45° field of view — 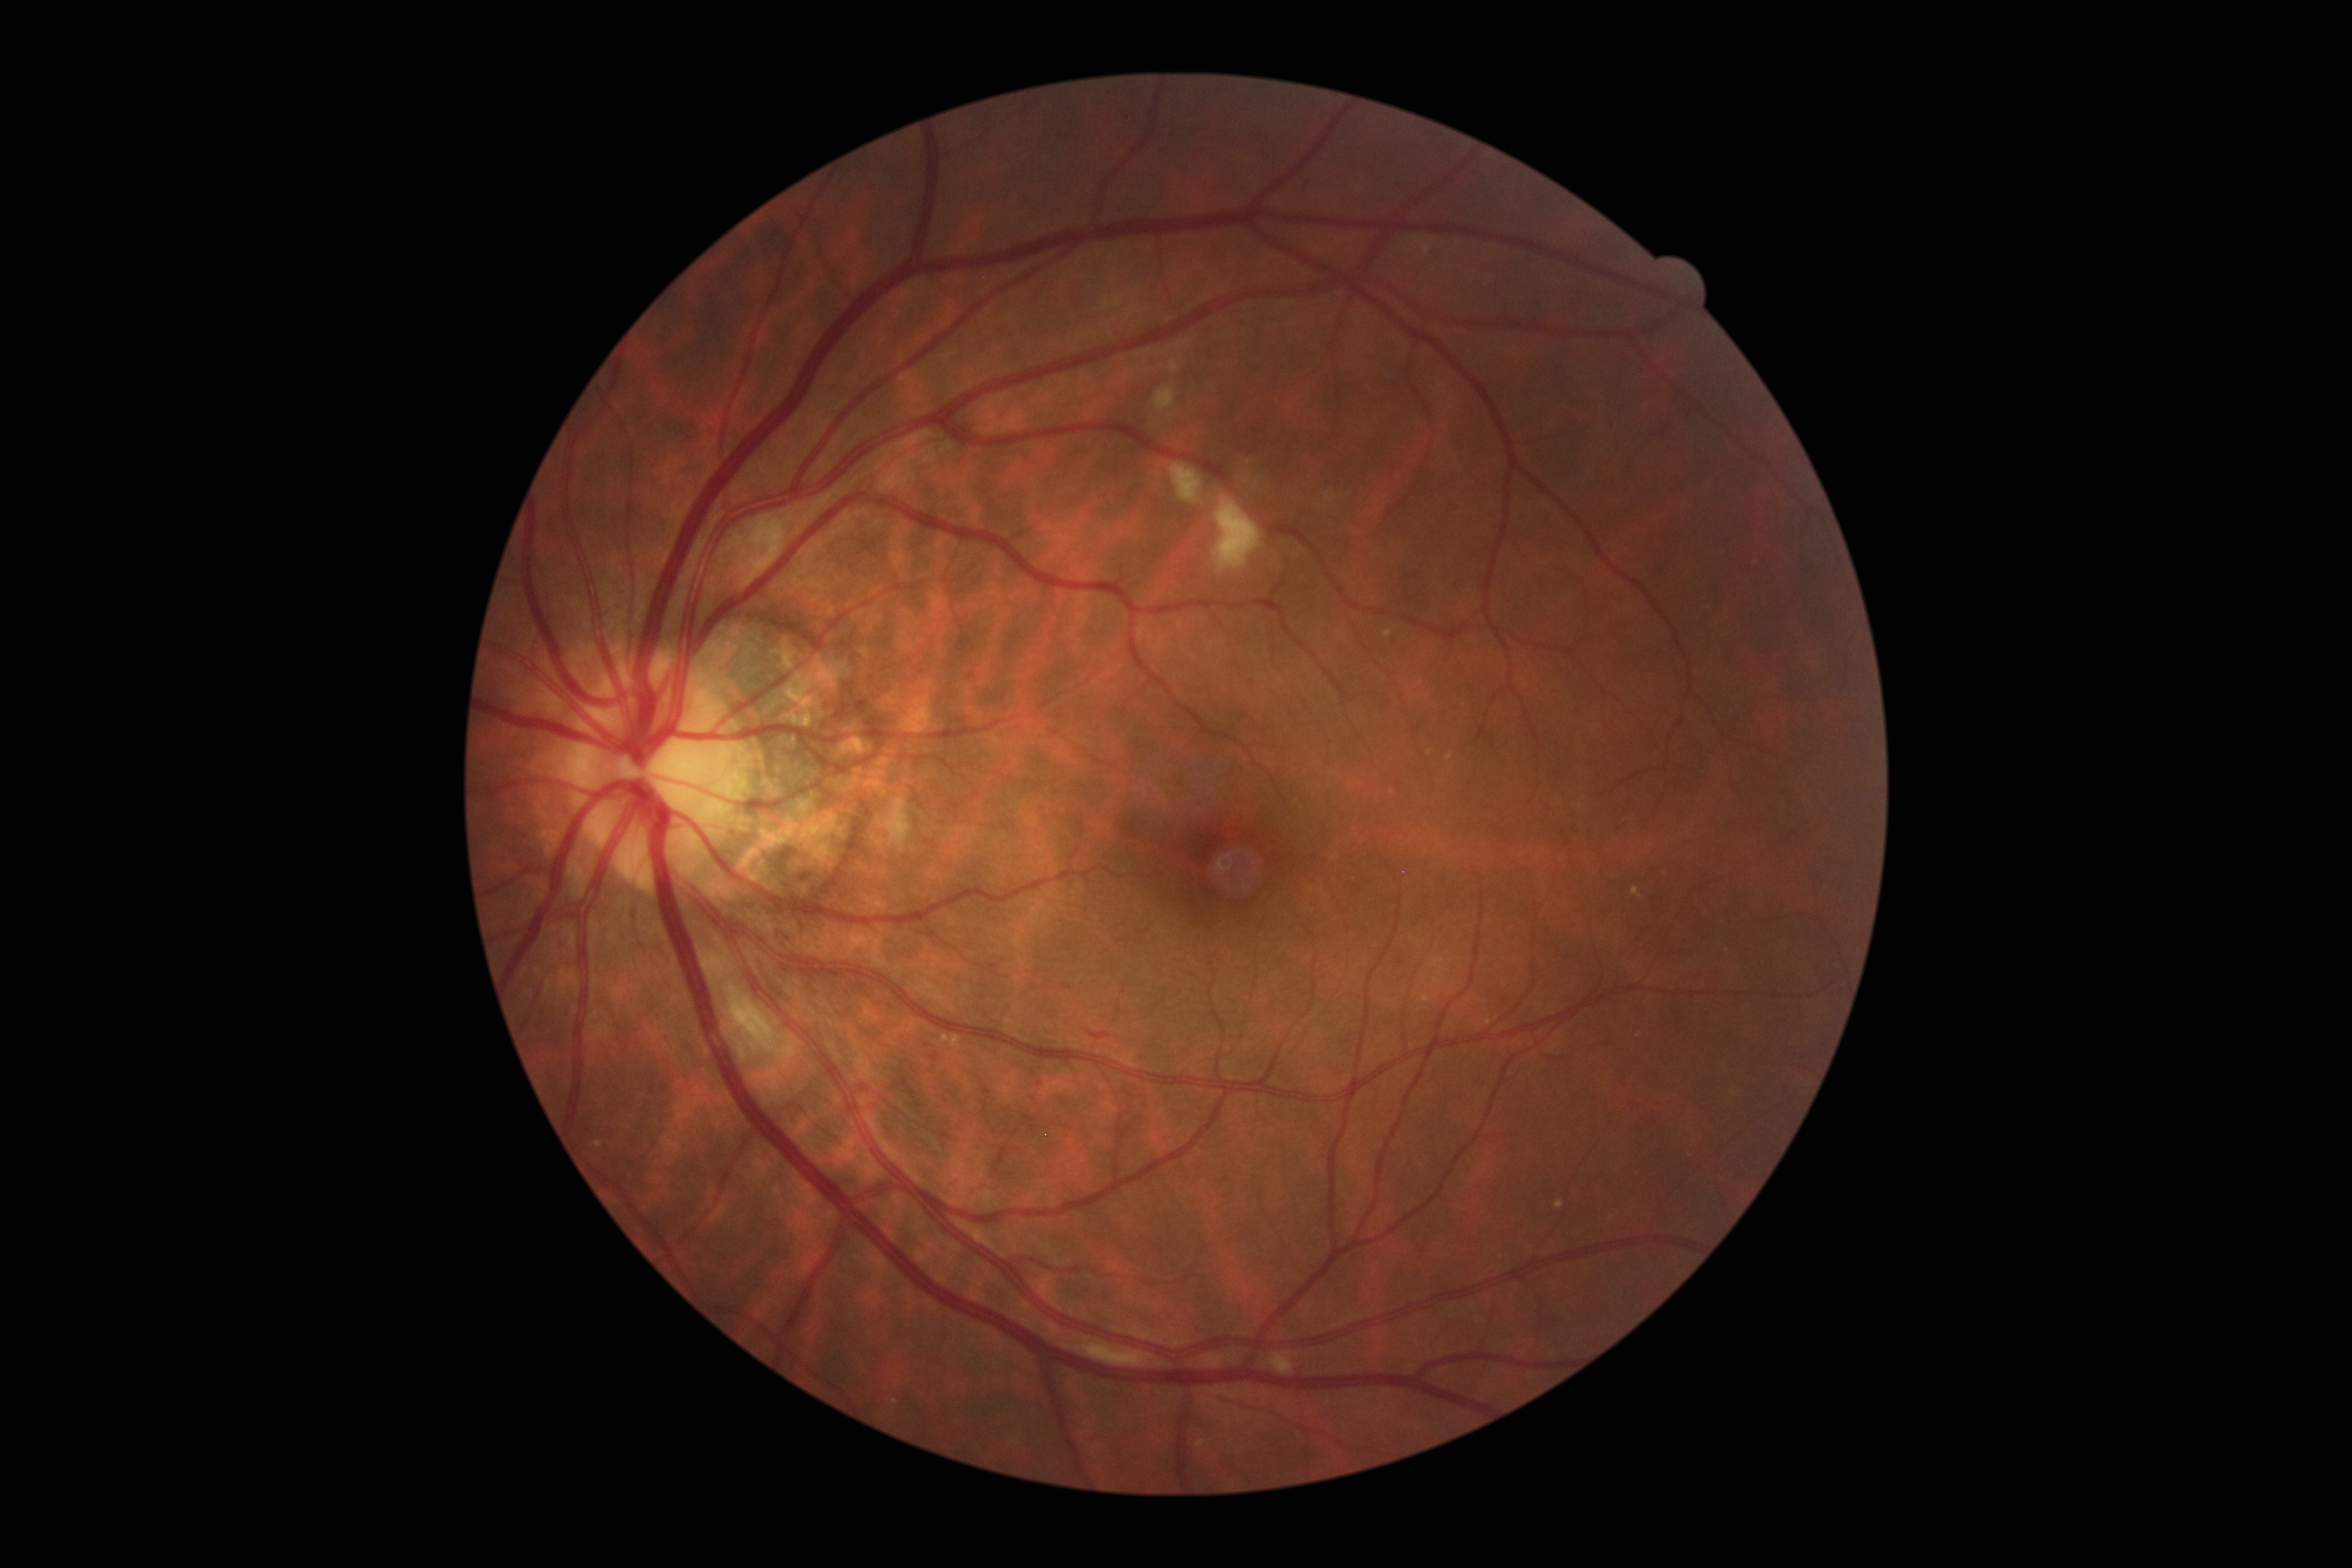
diabetic retinopathy grade = 2 (moderate NPDR)